2048 by 1536 pixels:
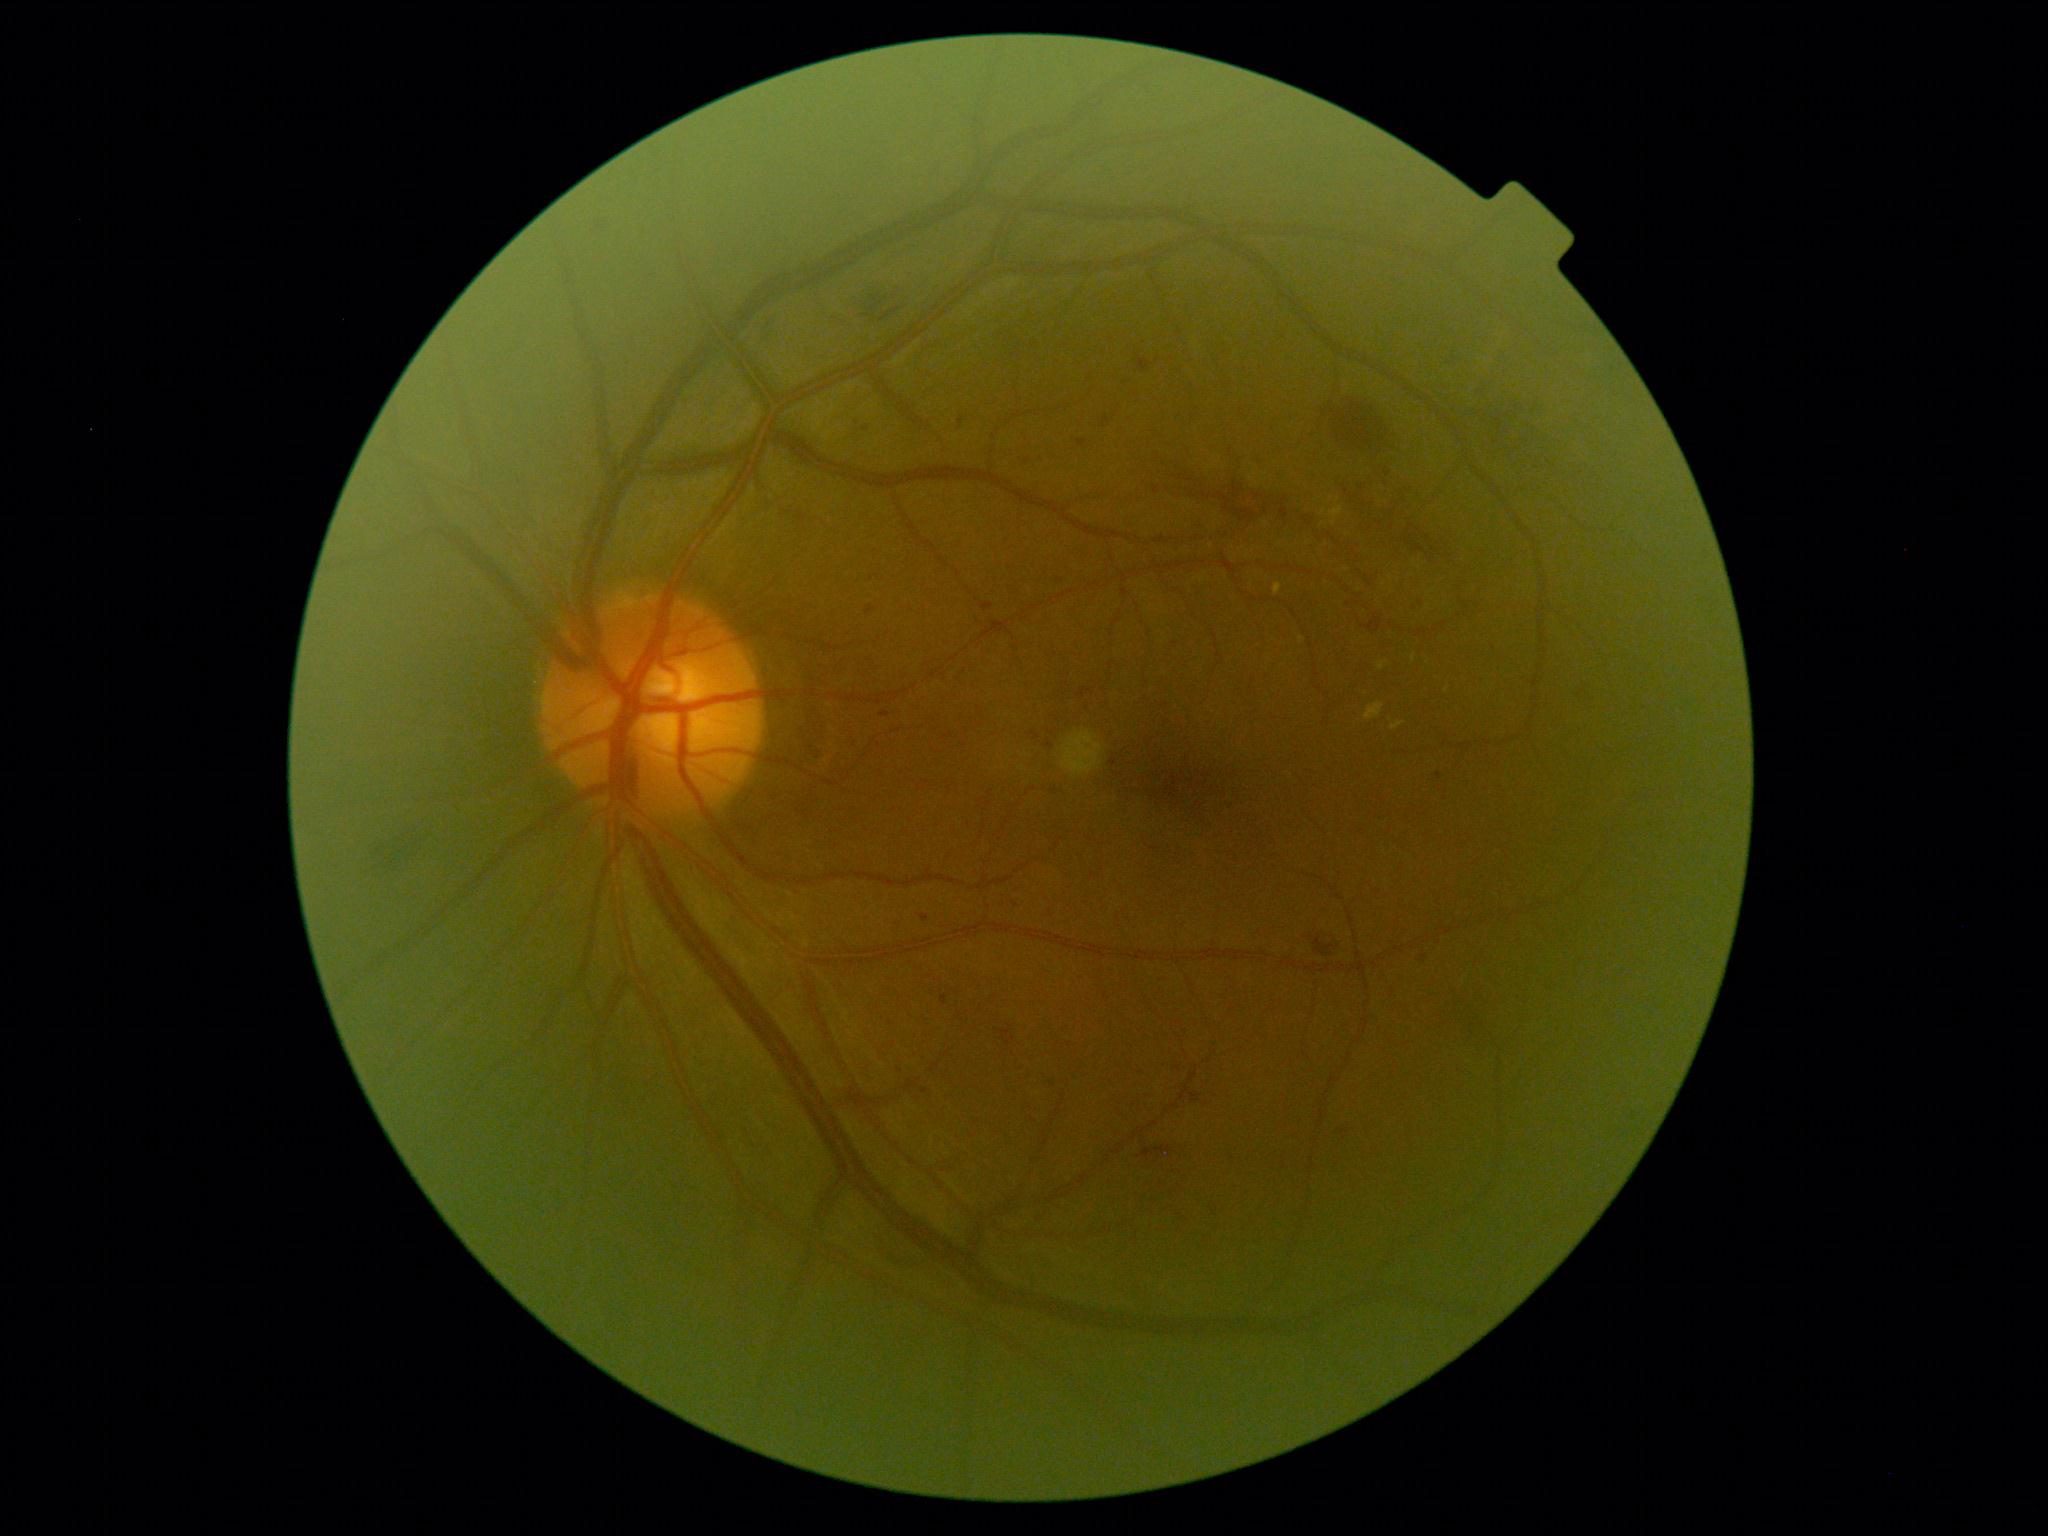 DR grade=moderate non-proliferative diabetic retinopathy (2), DR class=non-proliferative diabetic retinopathy.